Pediatric wide-field fundus photograph:
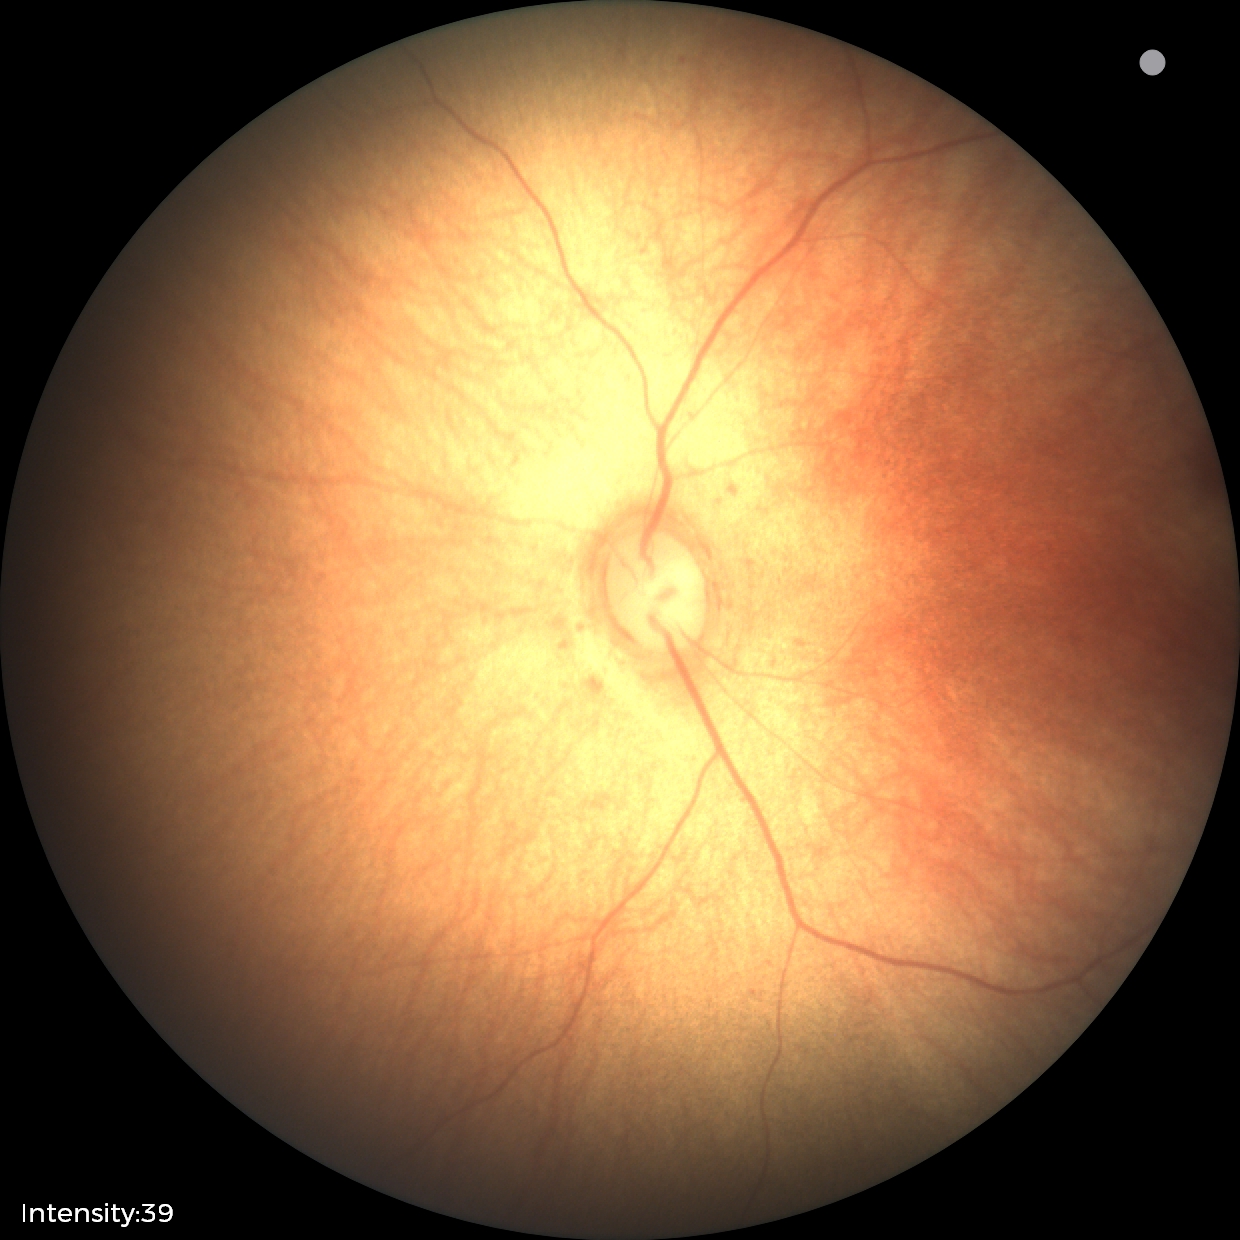 Screening examination with no abnormal retinal findings.